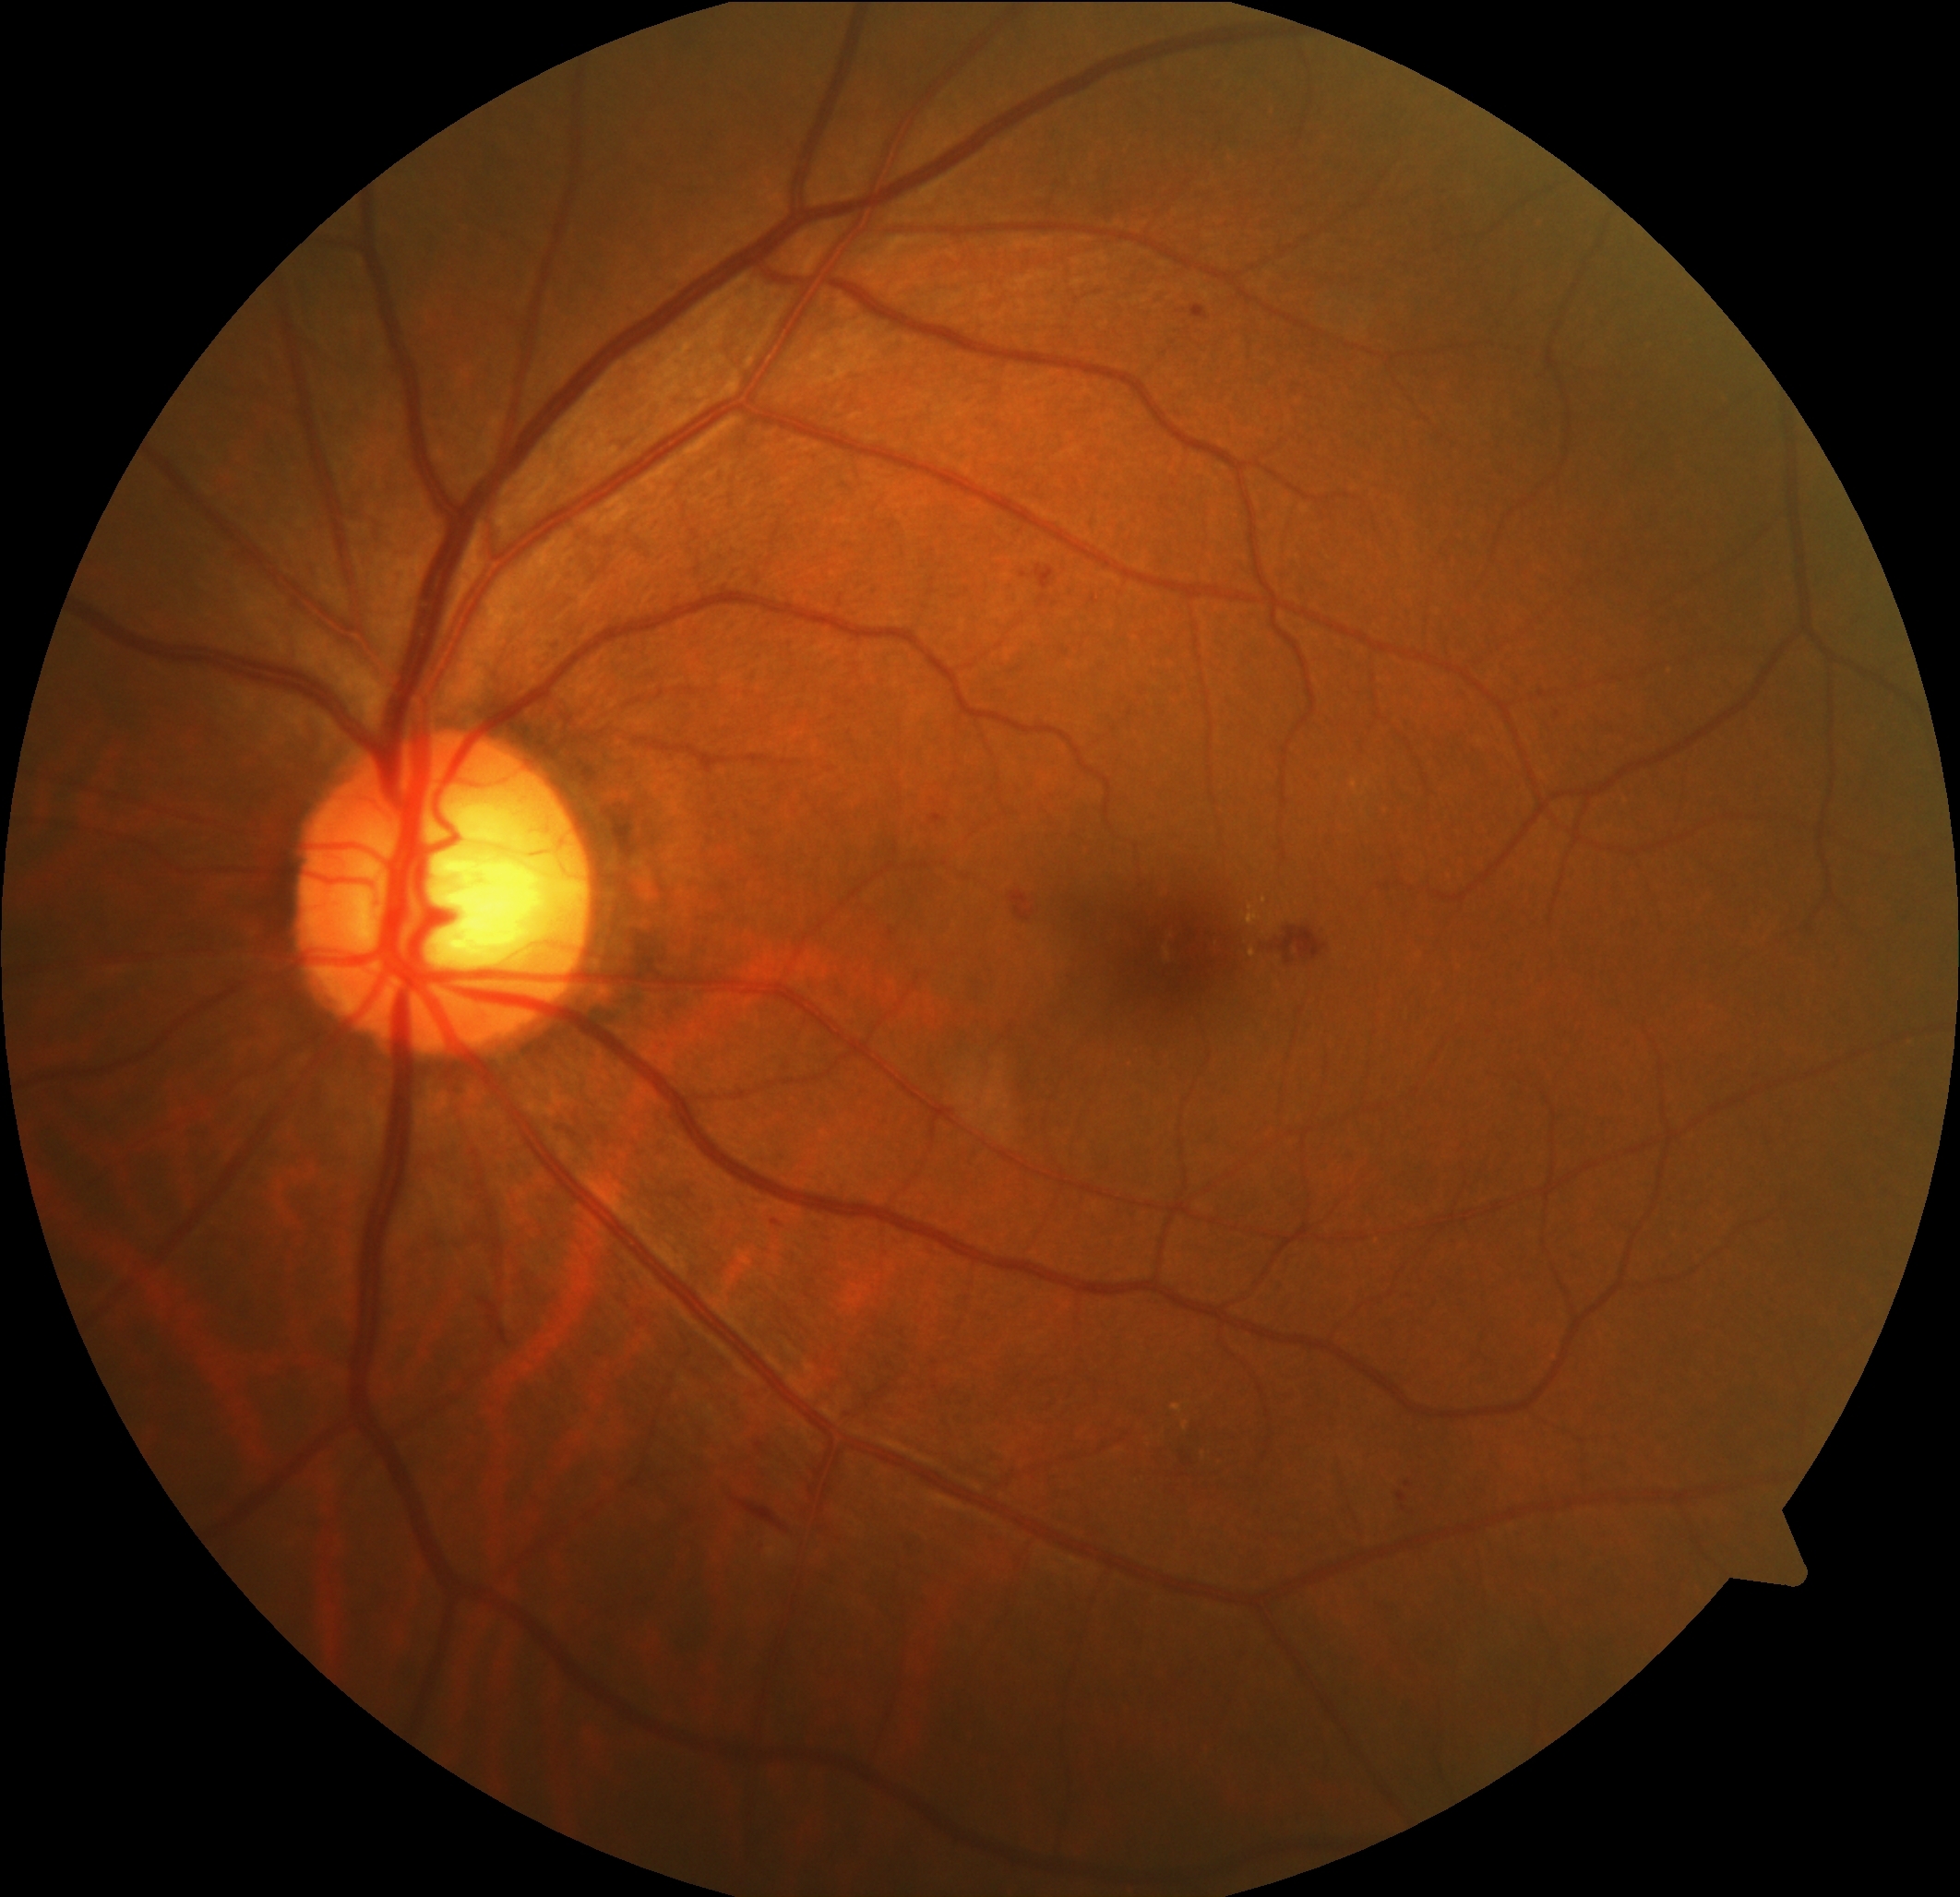 DR grade: 2 (moderate NPDR).
MAs located at bbox(1041, 595, 1046, 606) | bbox(1191, 306, 1209, 322) | bbox(773, 1219, 783, 1227) | bbox(1398, 1492, 1407, 1502) | bbox(932, 815, 943, 824) | bbox(1405, 1481, 1414, 1488).
Small MAs near {"x": 1403, "y": 1507} | {"x": 1056, "y": 604} | {"x": 1024, "y": 575}.
No SEs identified.
HEs located at bbox(1273, 927, 1329, 965) | bbox(1035, 564, 1056, 591) | bbox(735, 1500, 786, 1531) | bbox(1009, 890, 1037, 922).
EXs include bbox(1352, 780, 1358, 790) | bbox(1247, 906, 1261, 925) | bbox(1173, 1404, 1182, 1412) | bbox(1251, 949, 1257, 958).
Small EXs near {"x": 1265, "y": 900} | {"x": 1186, "y": 1425}.